45° FOV
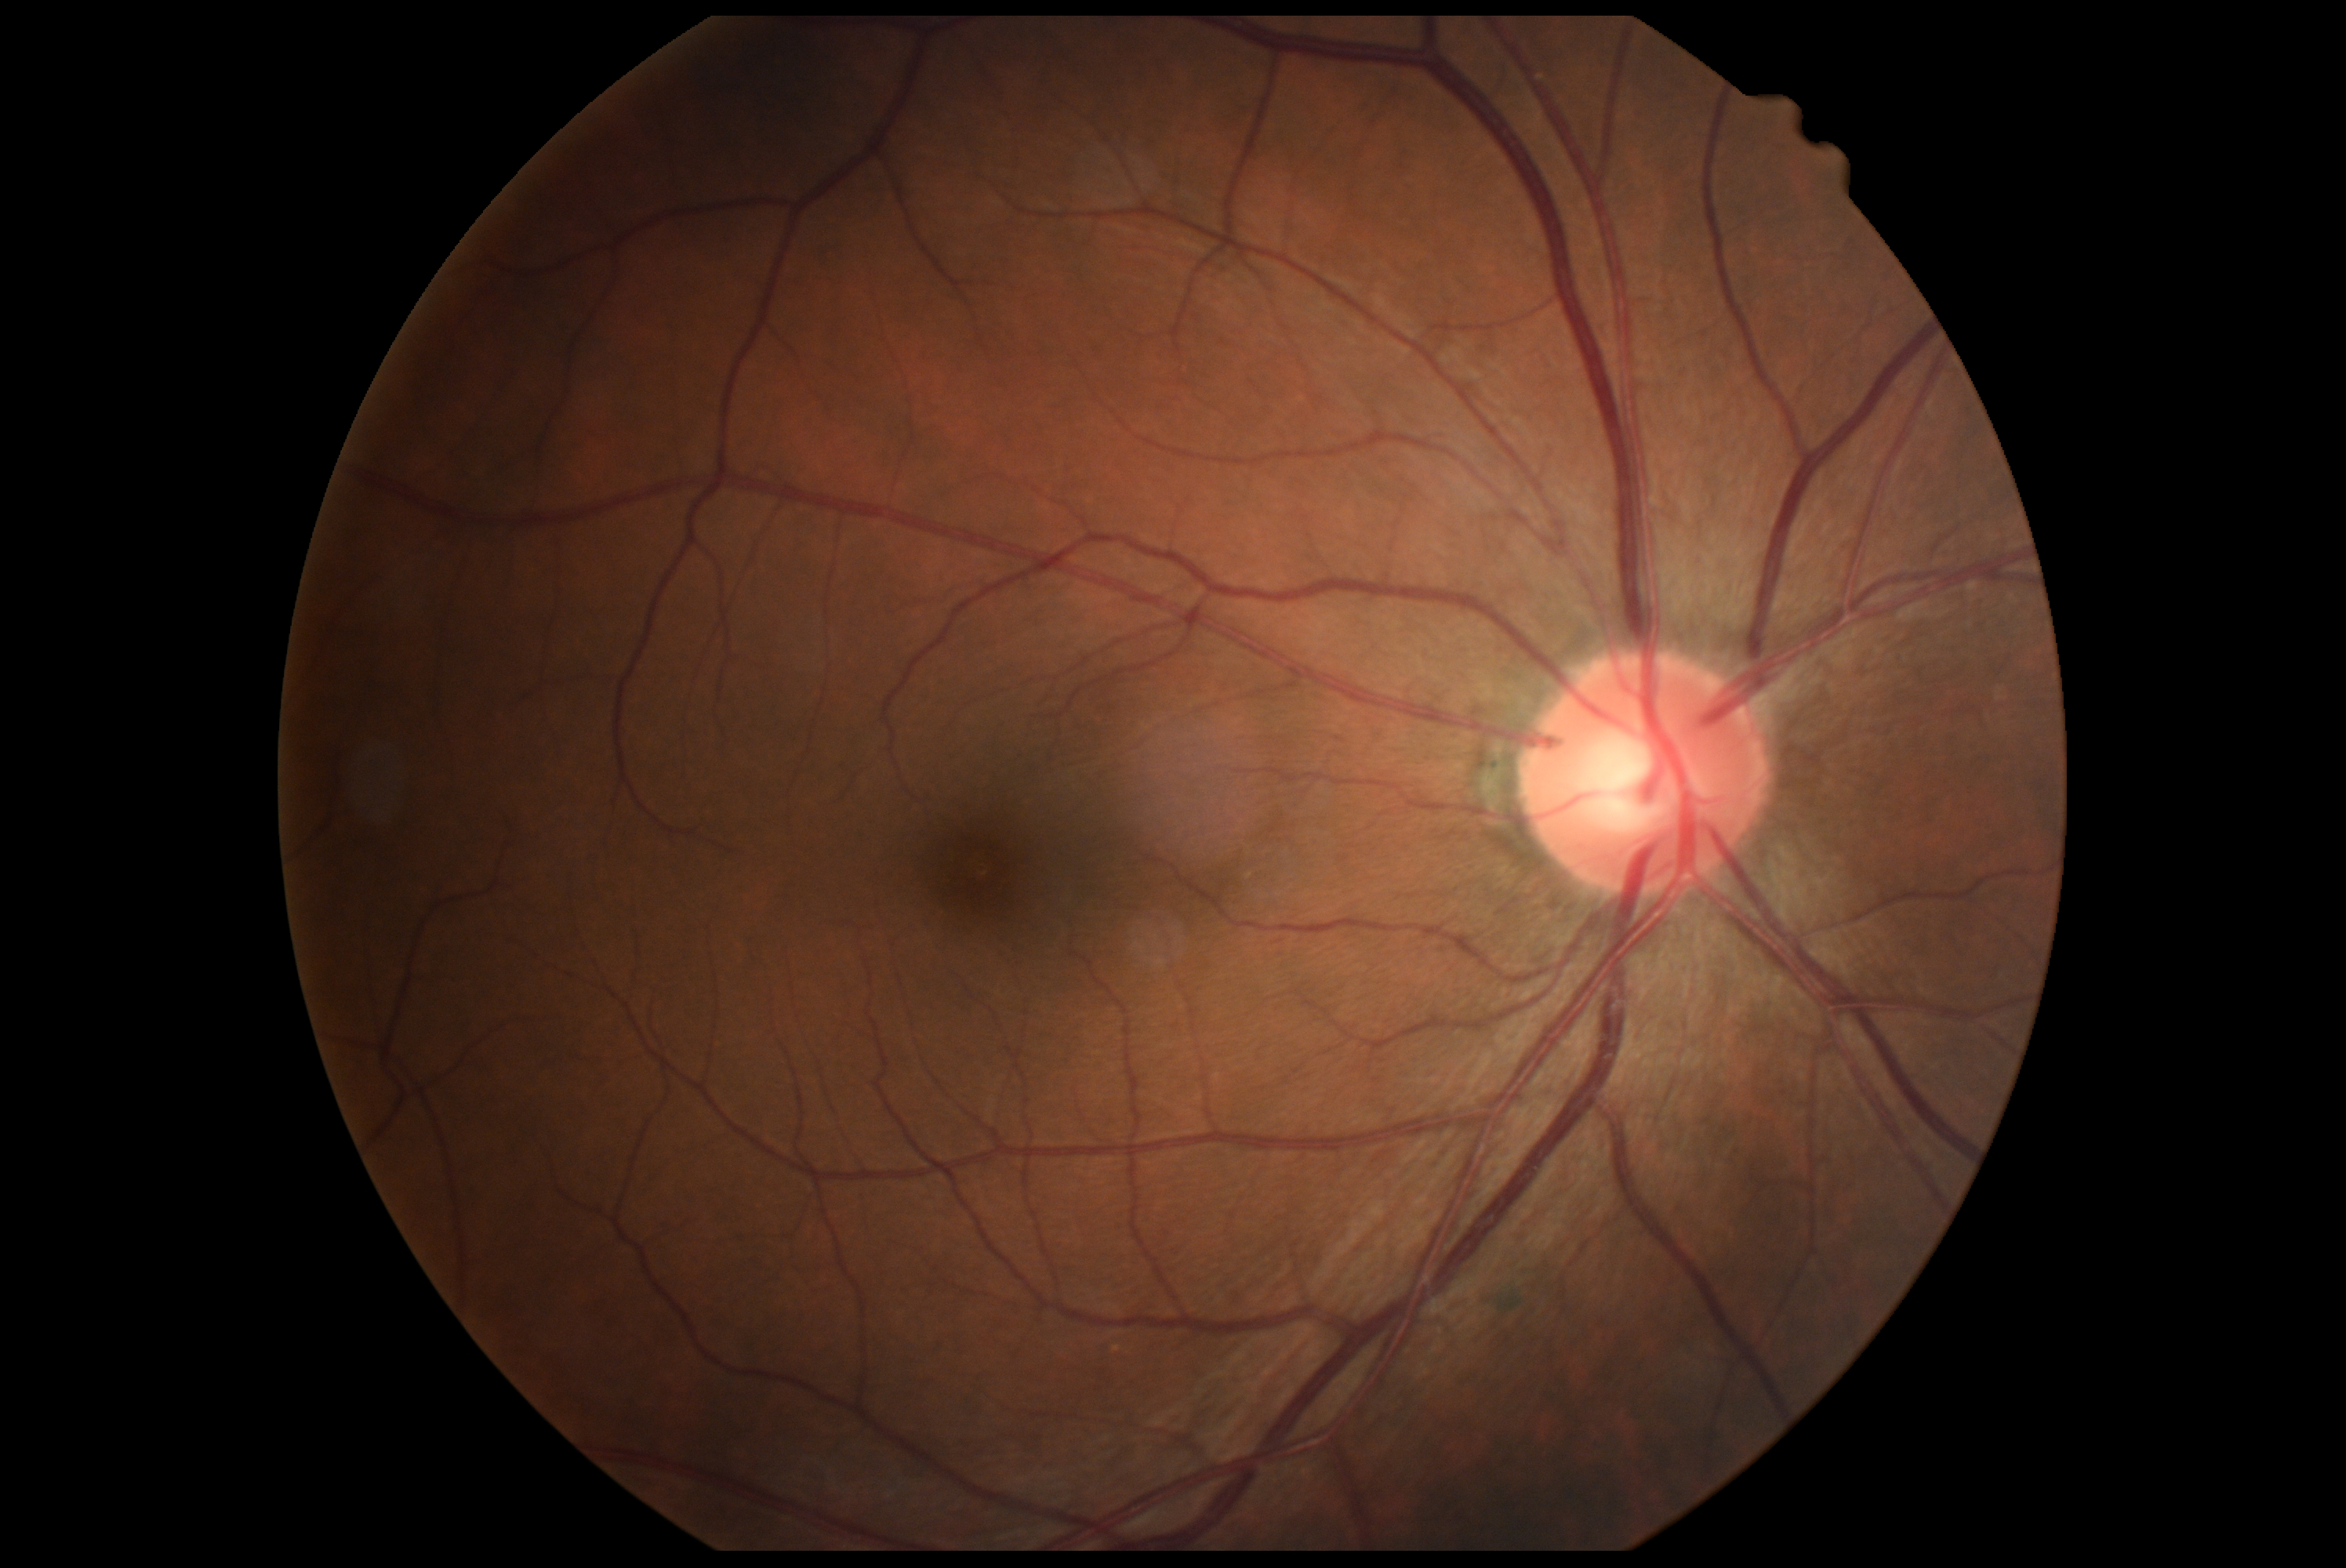 Diabetic retinopathy (DR): no apparent retinopathy (grade 0) — no visible signs of diabetic retinopathy.